240 by 240 pixels, cropped to the optic nerve head.
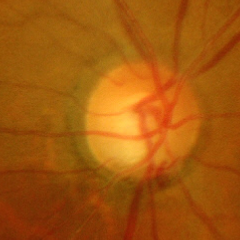 The image shows severe glaucomatous damage.